45° field of view · 848 by 848 pixels:
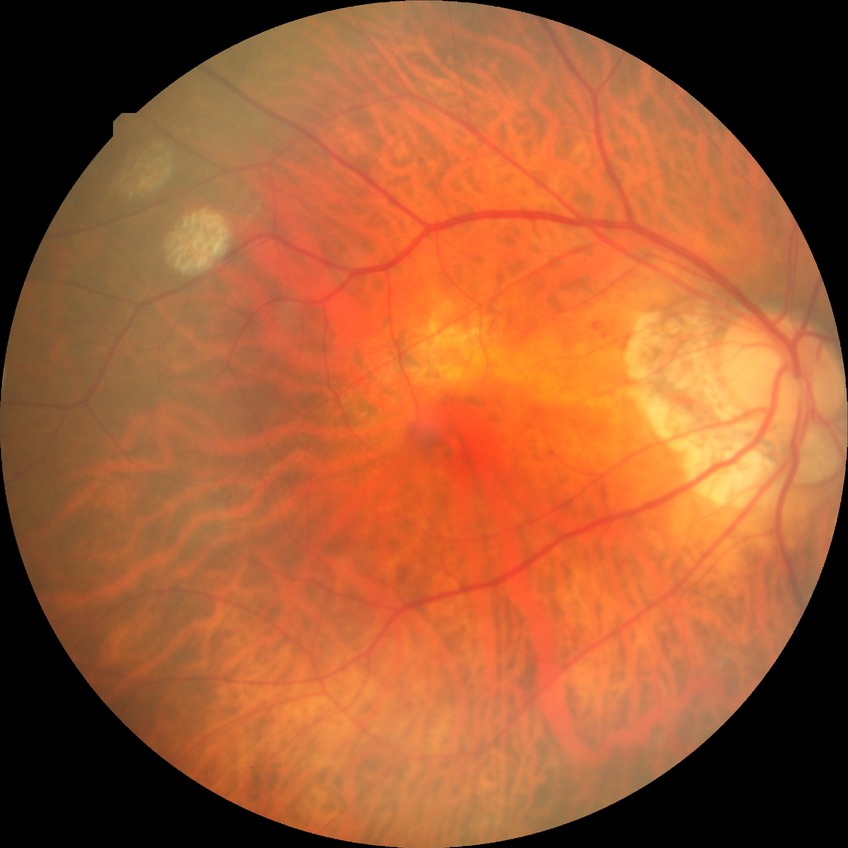

Diabetic retinopathy (DR): simple diabetic retinopathy (SDR).